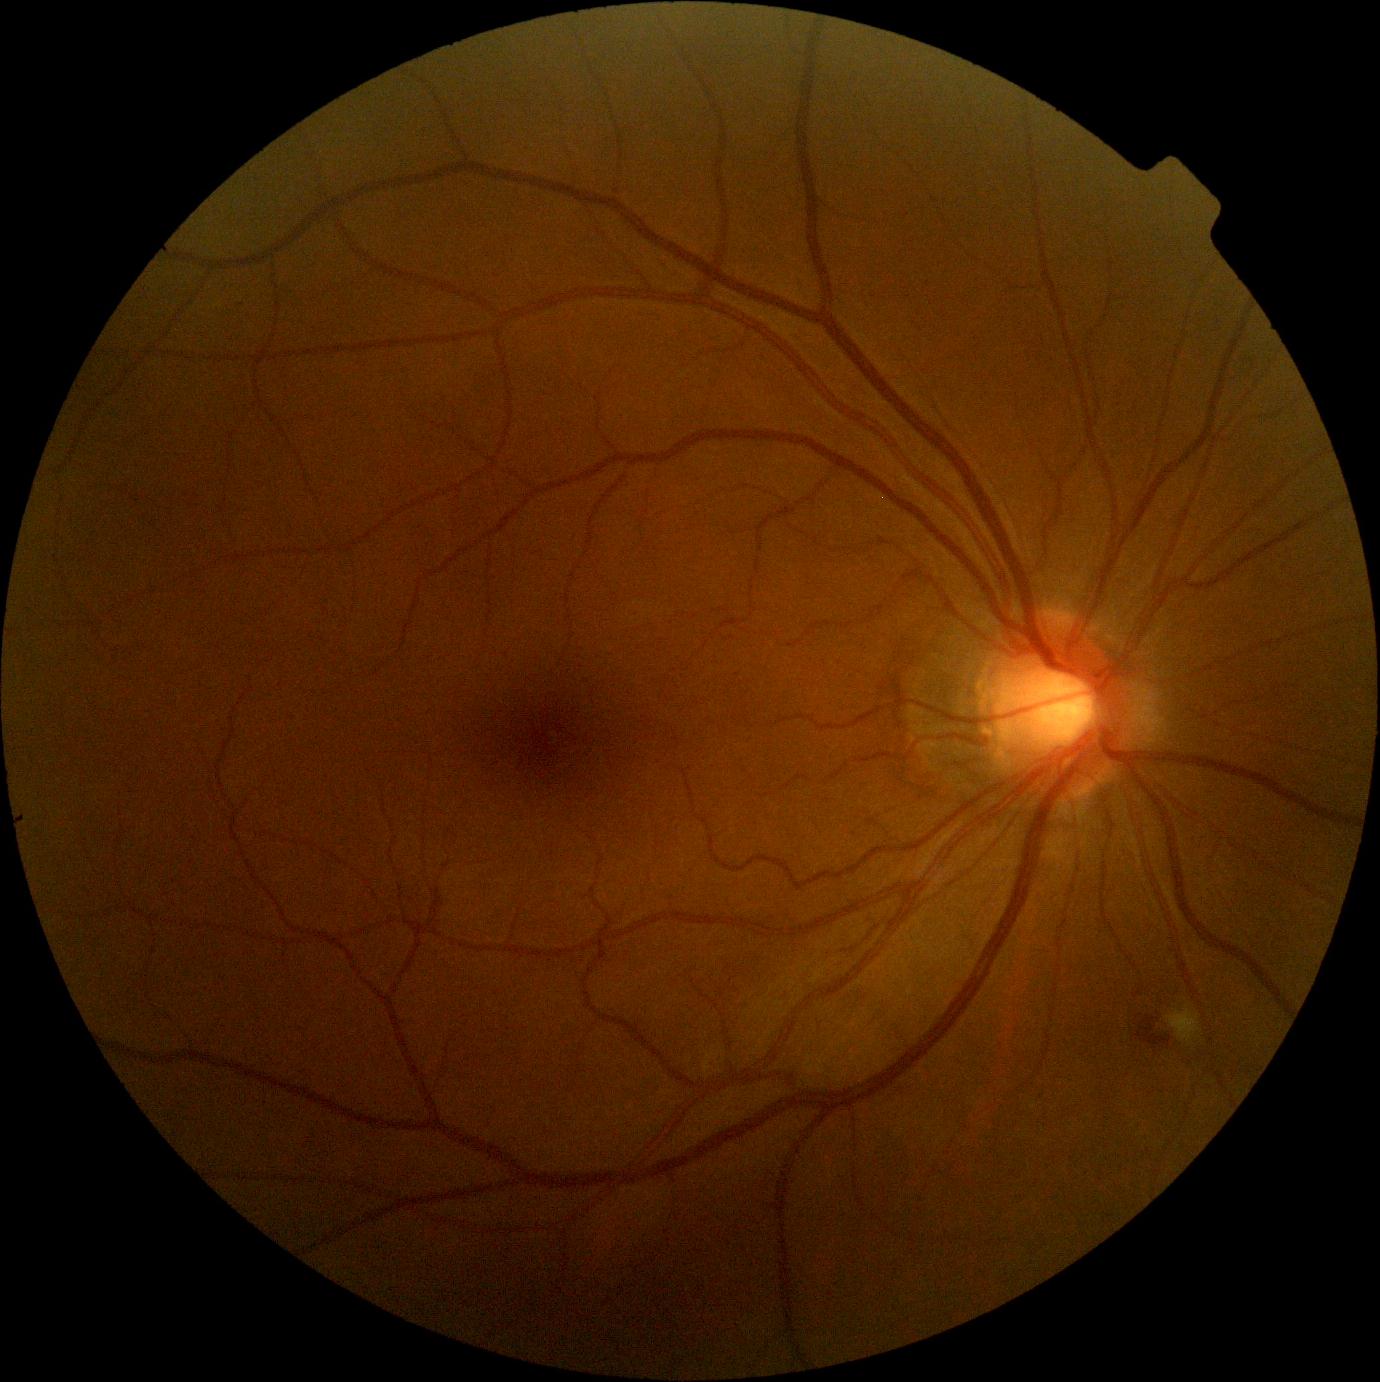
retinopathy=moderate NPDR (grade 2).